2352 x 1568 pixels · color fundus photograph.
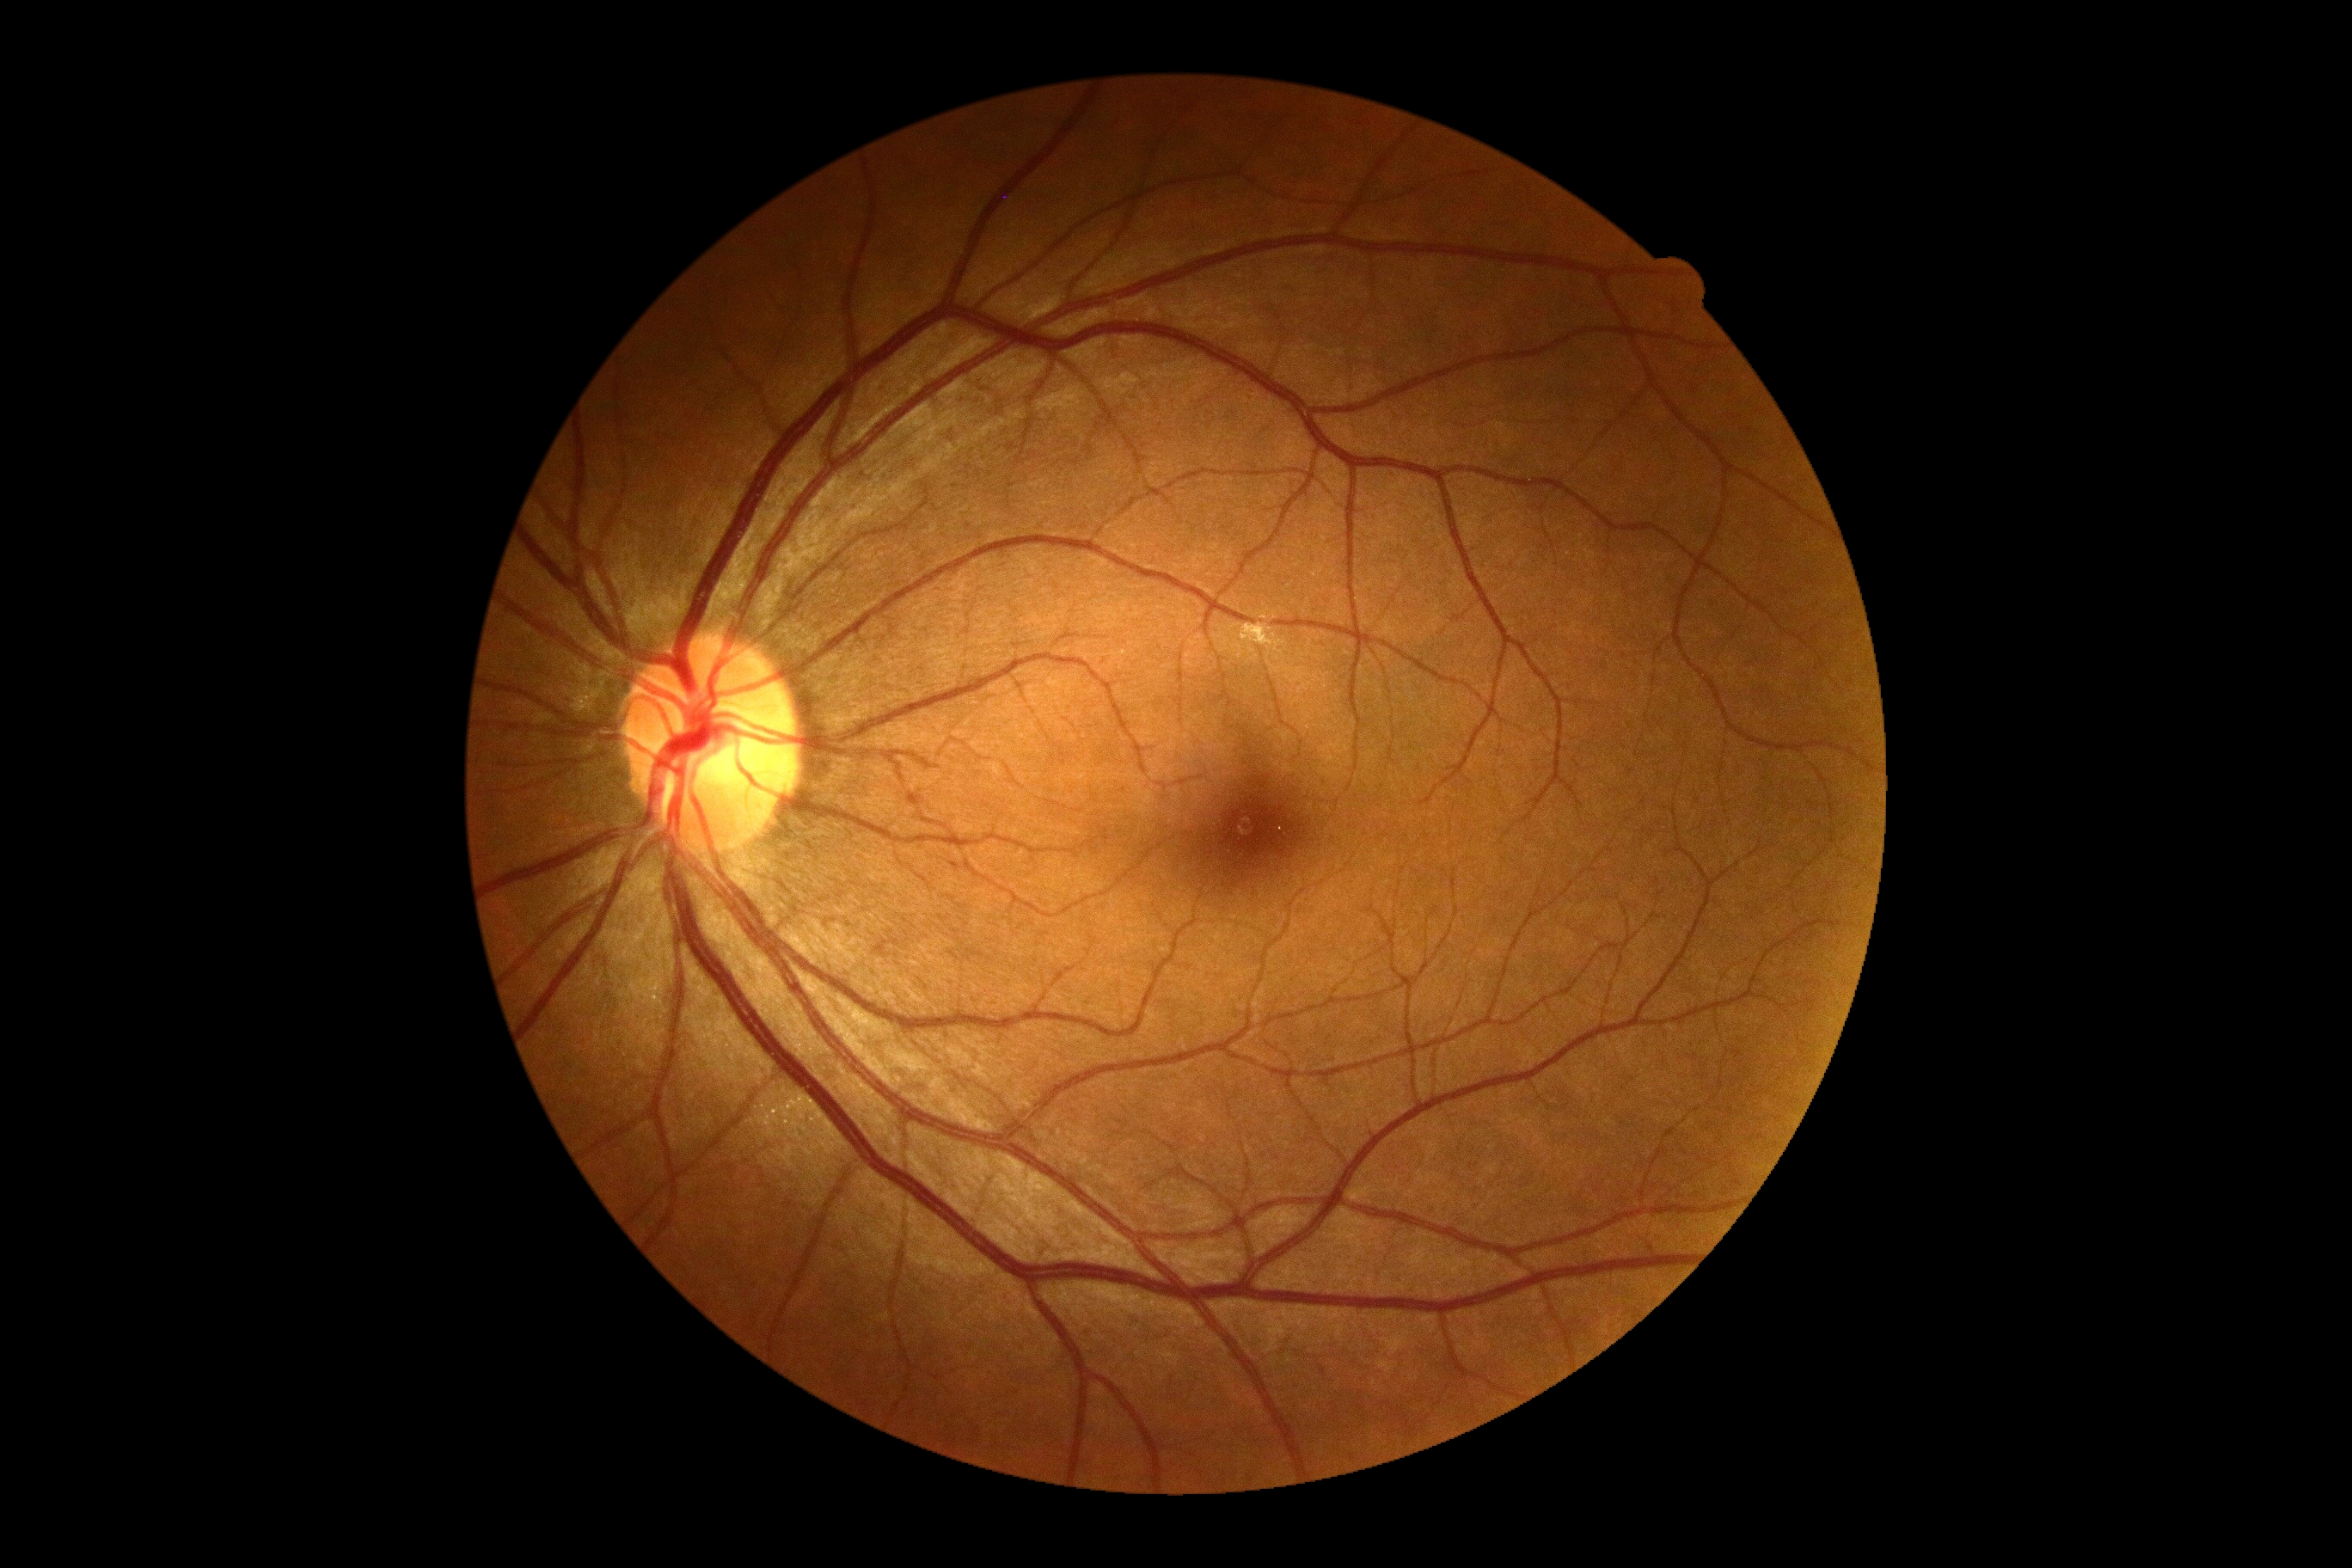 Findings:
– DR grade — 0 (no apparent retinopathy)